Camera: Clarity RetCam 3 (130° FOV). Wide-field fundus image from infant ROP screening — 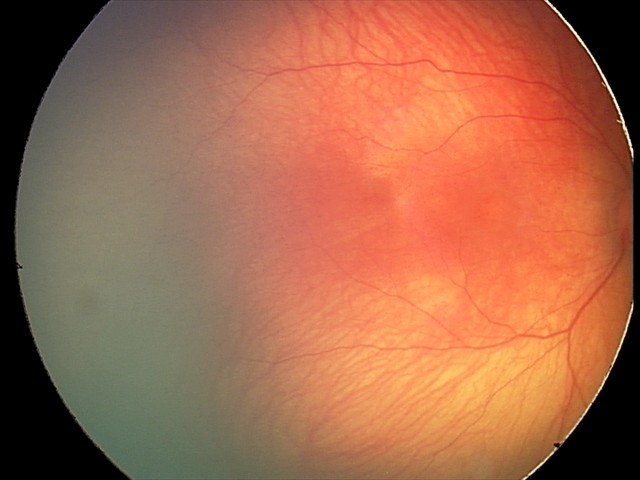 No retinal pathology identified on screening.